45° FOV · color fundus image · 1960x1897 — 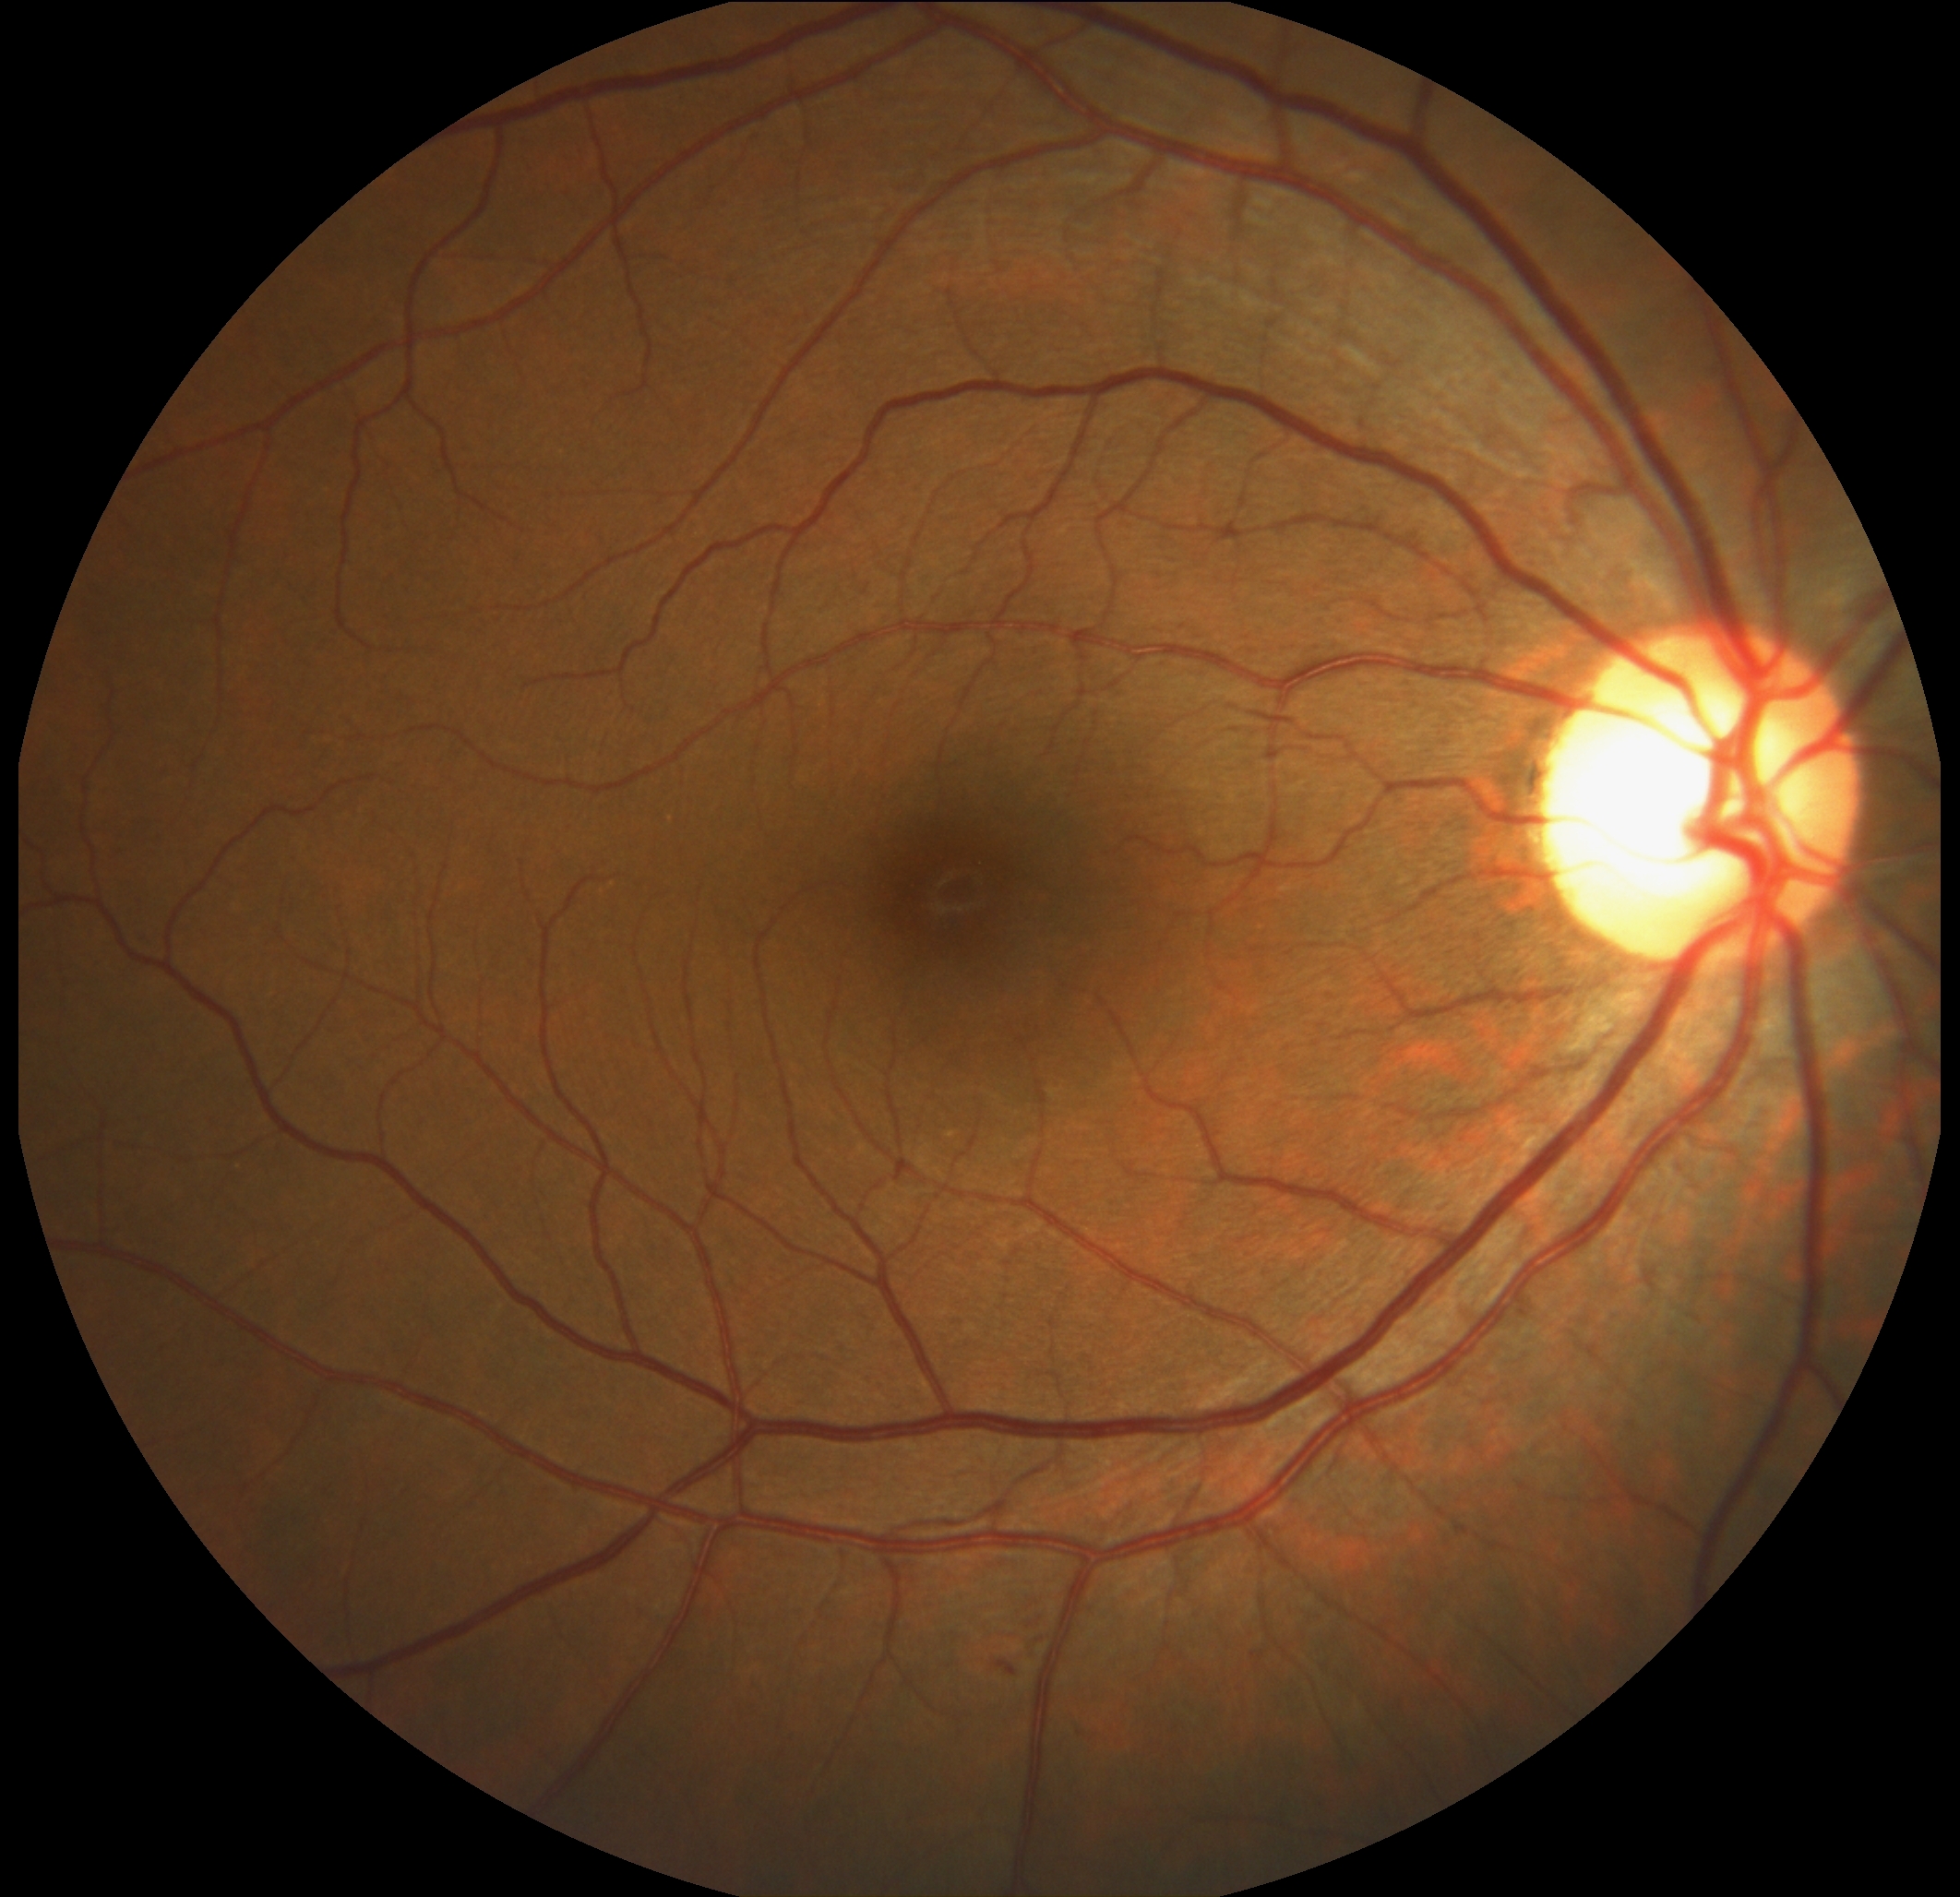

  dr_category: non-proliferative diabetic retinopathy
  dr_grade: grade 2 (moderate NPDR) — more than just microaneurysms but less than severe NPDR